Infant wide-field fundus photograph
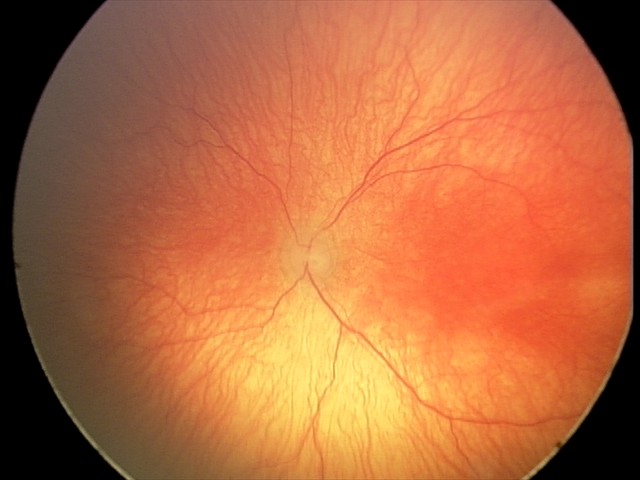
Impression = aggressive retinopathy of prematurity — rapidly progressive severe ROP with prominent plus disease, often without classic stage progression.